2048x1536, FOV: 45 degrees — 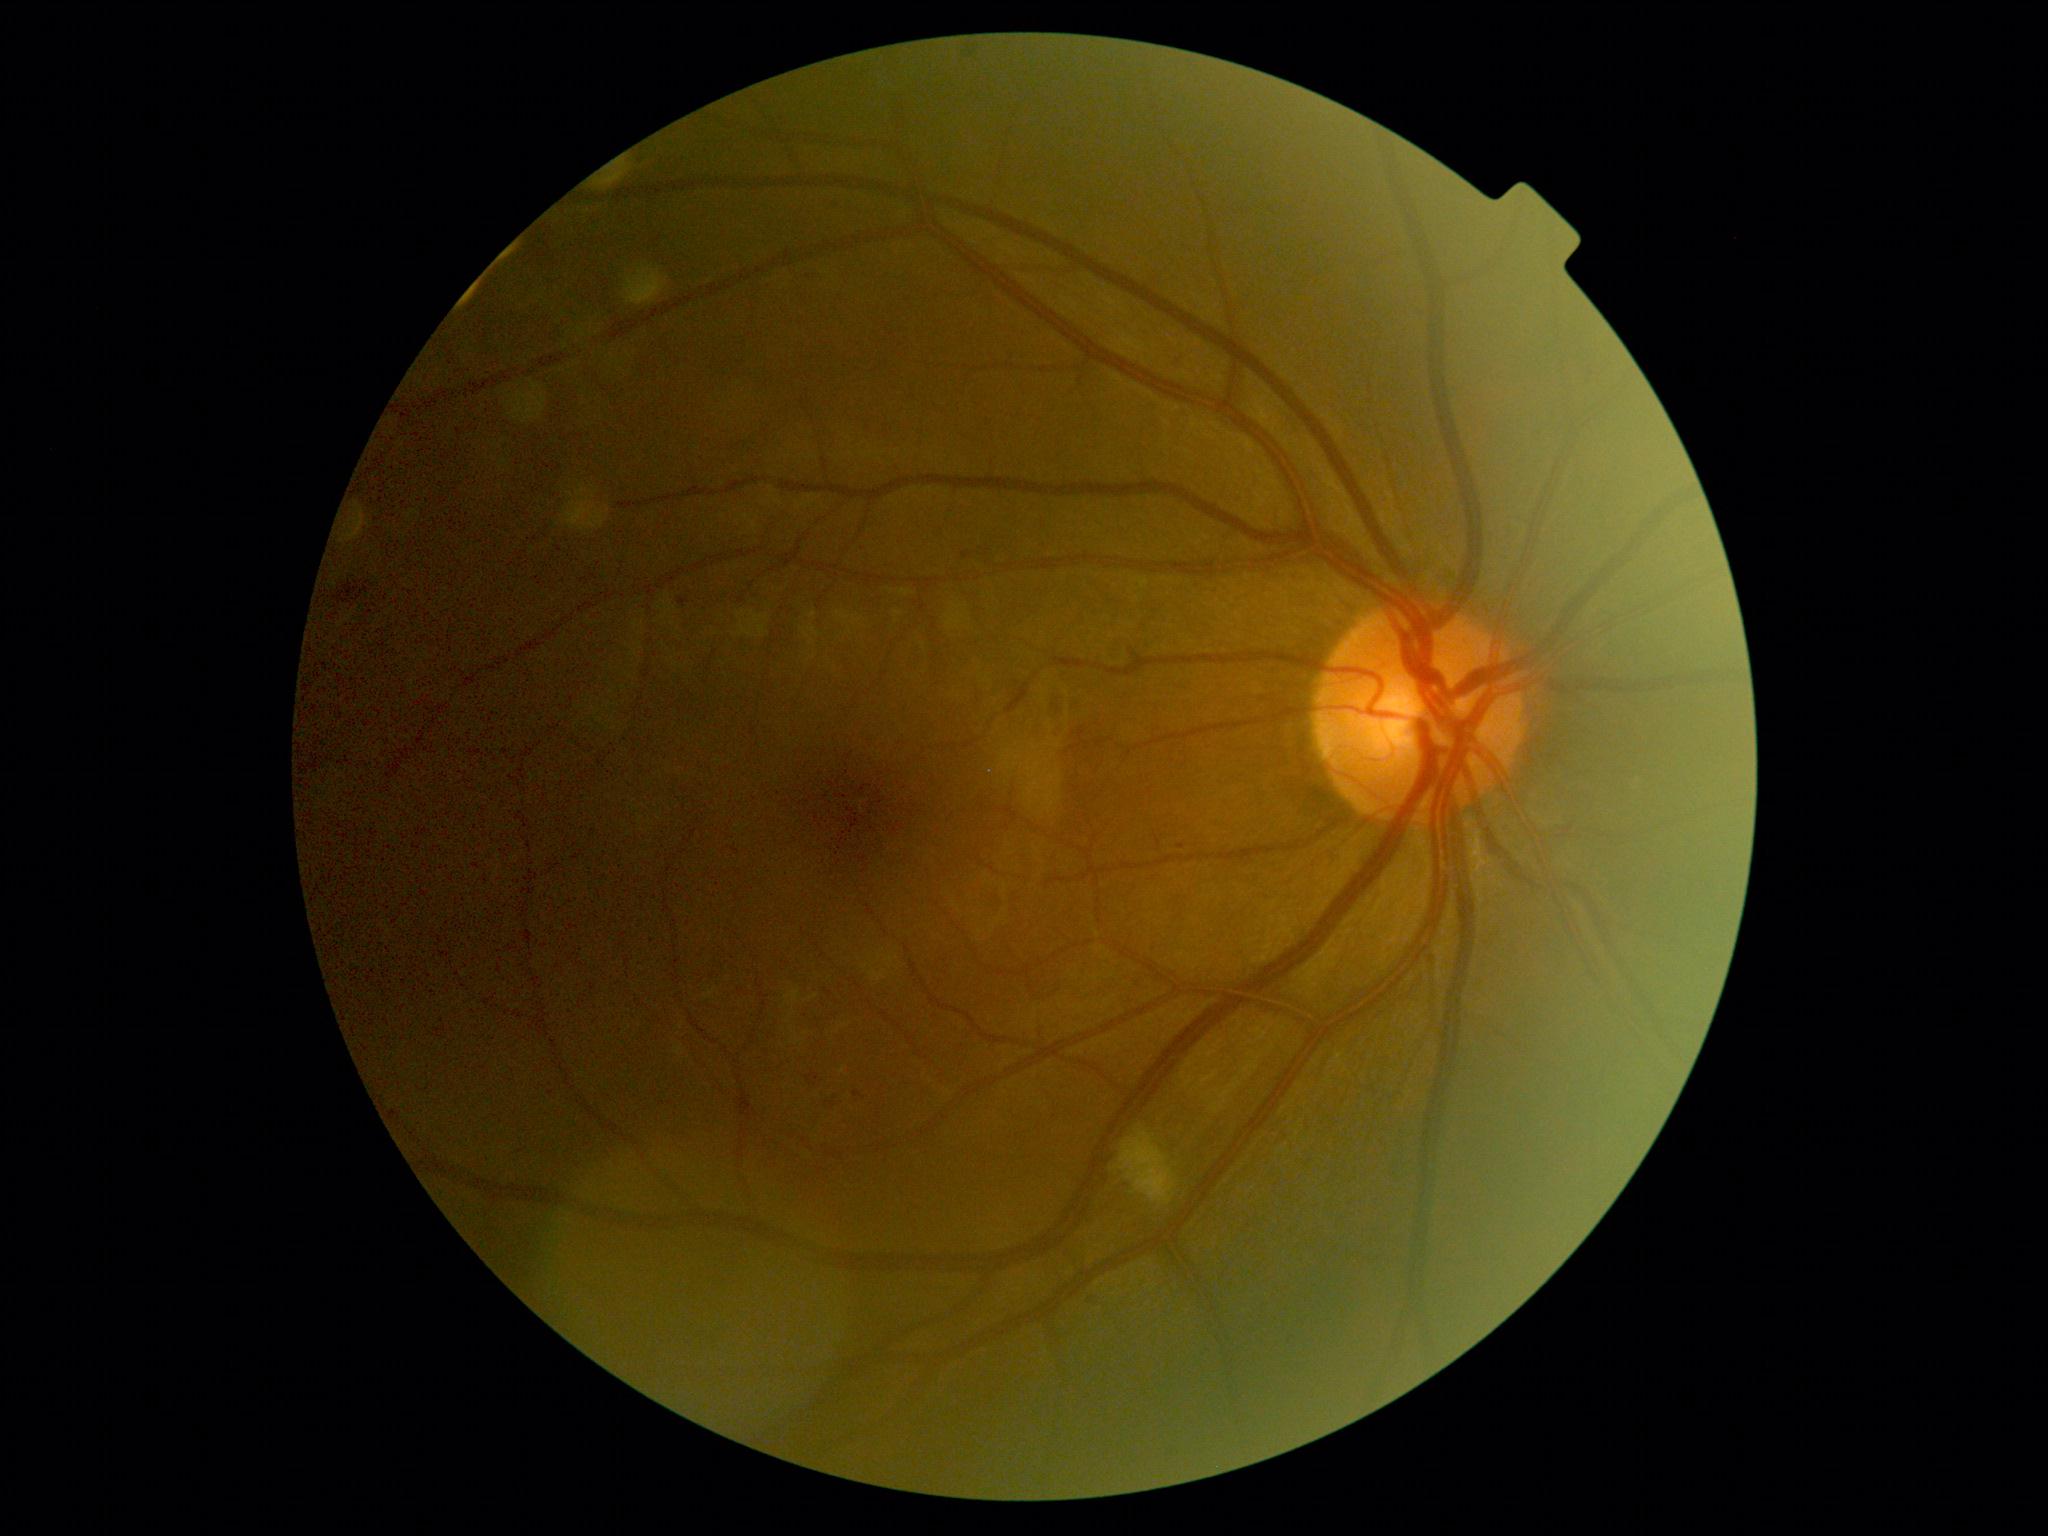 Disease class: non-proliferative diabetic retinopathy. DR stage: moderate NPDR (grade 2) — more than just microaneurysms but less than severe NPDR.